Camera: NIDEK AFC-230. Nonmydriatic. 848 by 848 pixels. Fundus photo. Modified Davis grading
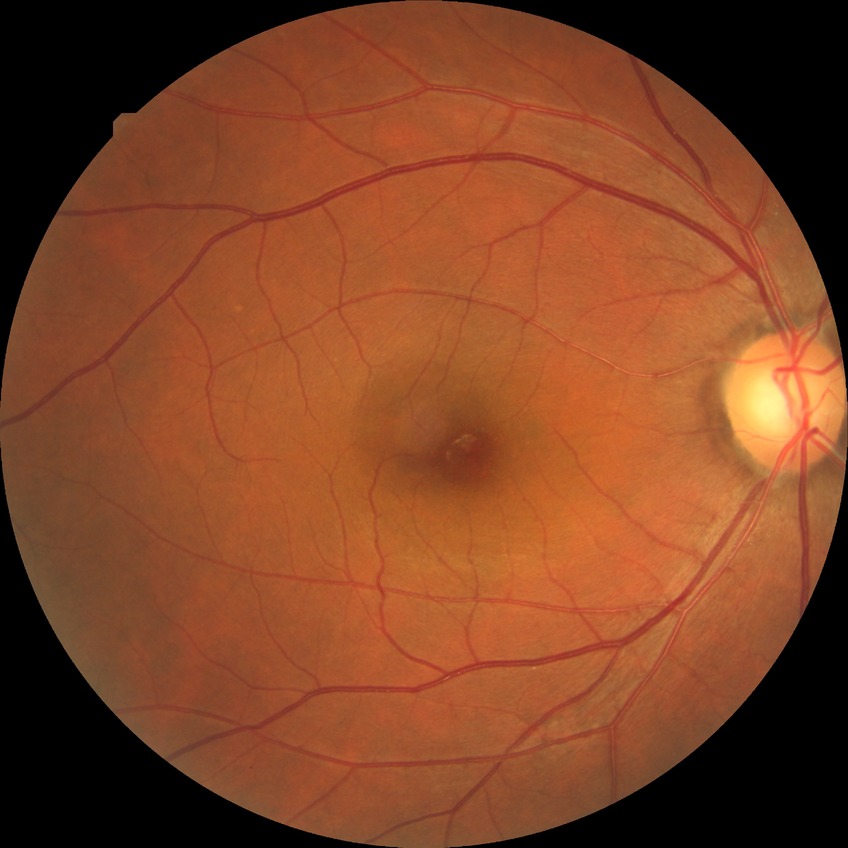
diabetic retinopathy (DR) = NDR (no diabetic retinopathy).